Clarity RetCam 3, 130° FOV · 640 x 480 pixels · wide-field fundus photograph of an infant — 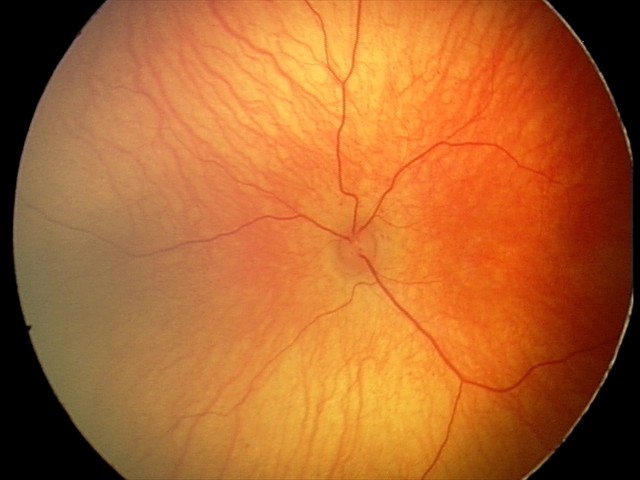

Screening diagnosis: physiological appearance